45-degree field of view: 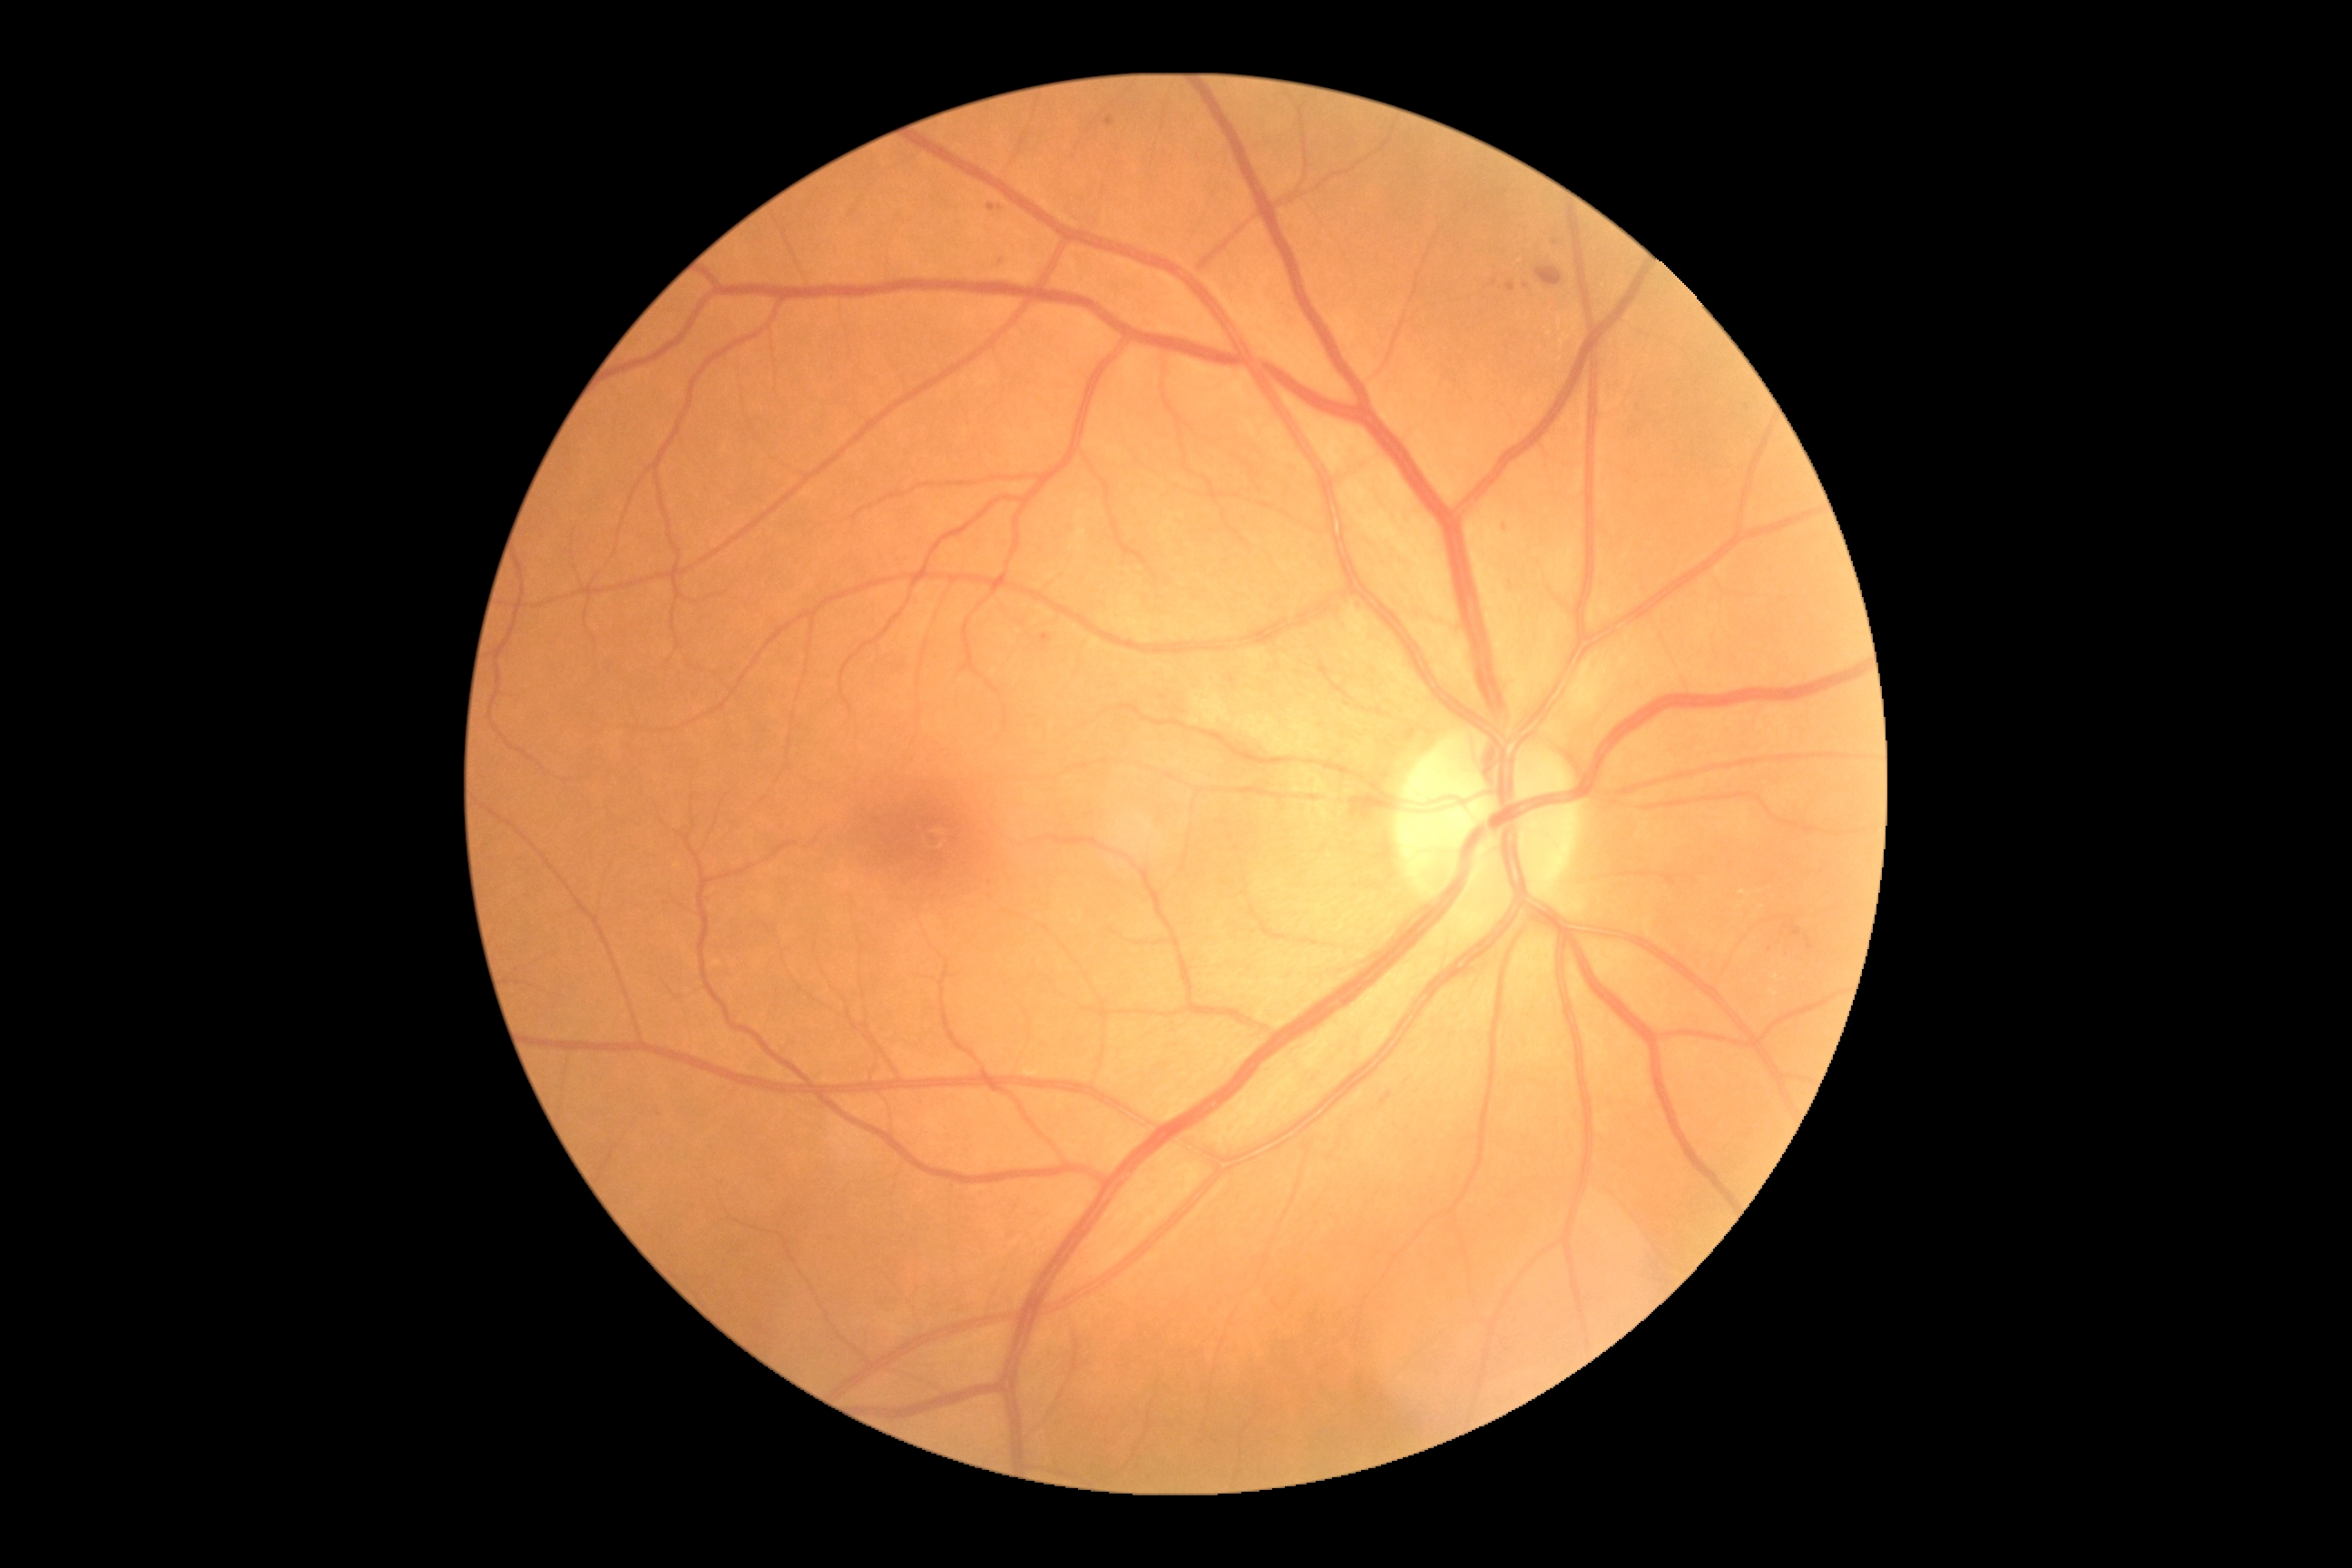

DR is grade 2 — more than just microaneurysms but less than severe NPDR.